Modified Davis classification.
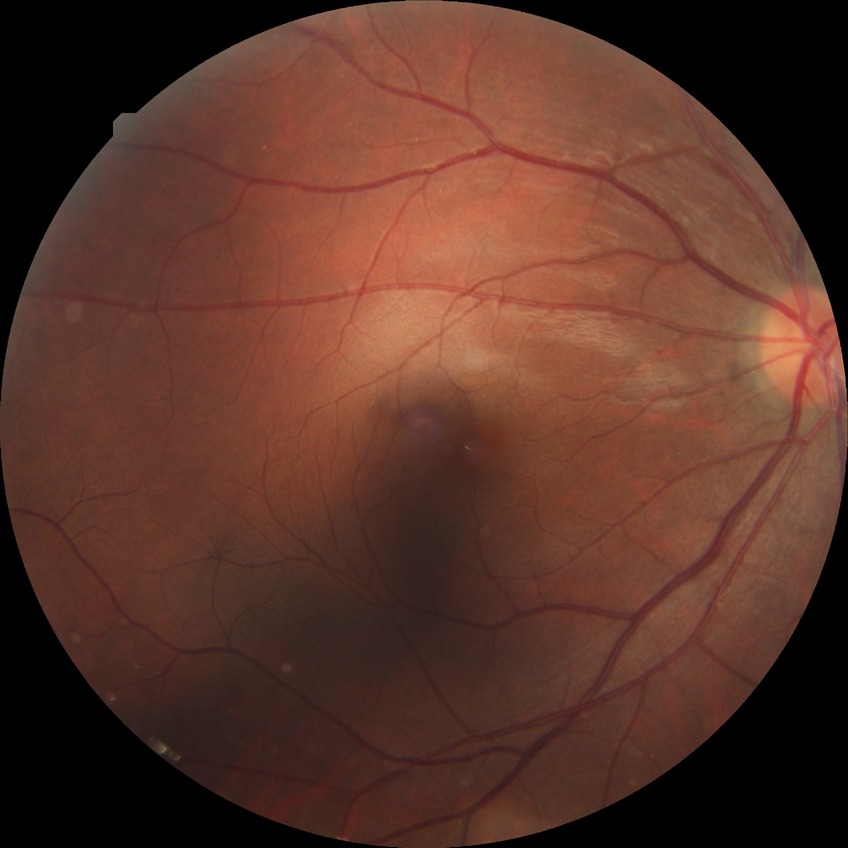

Diabetic retinopathy (DR) is no diabetic retinopathy (NDR).